FOV: 45 degrees, 848 by 848 pixels, graded on the modified Davis scale:
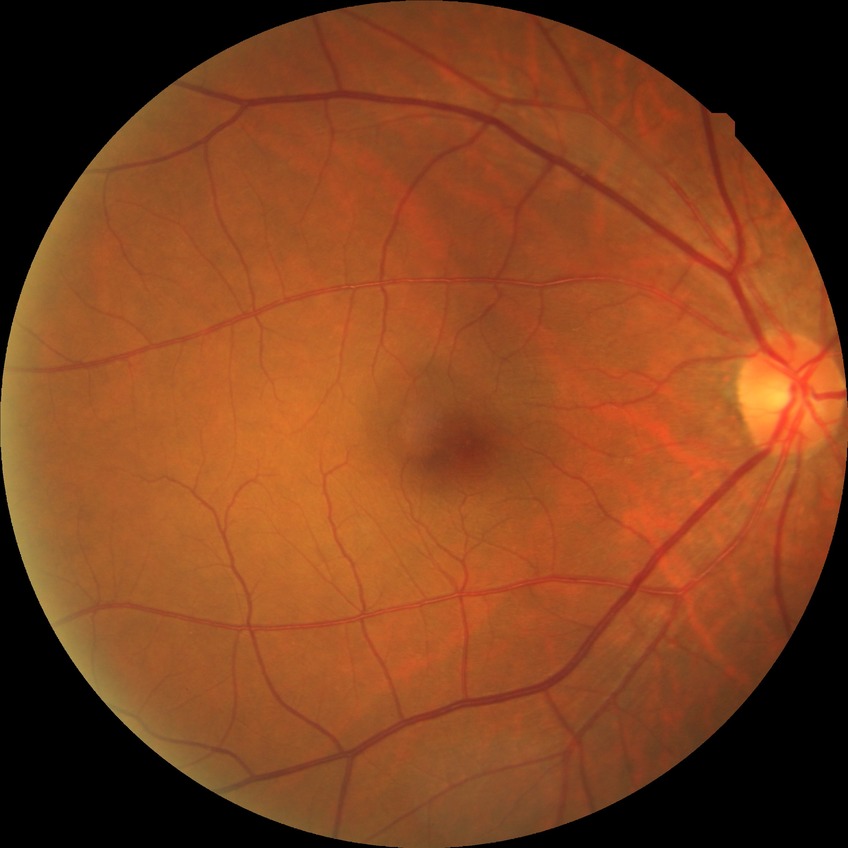

Diabetic retinopathy (DR): no diabetic retinopathy (NDR).